Color fundus image; 45° FOV; 2212x1659:
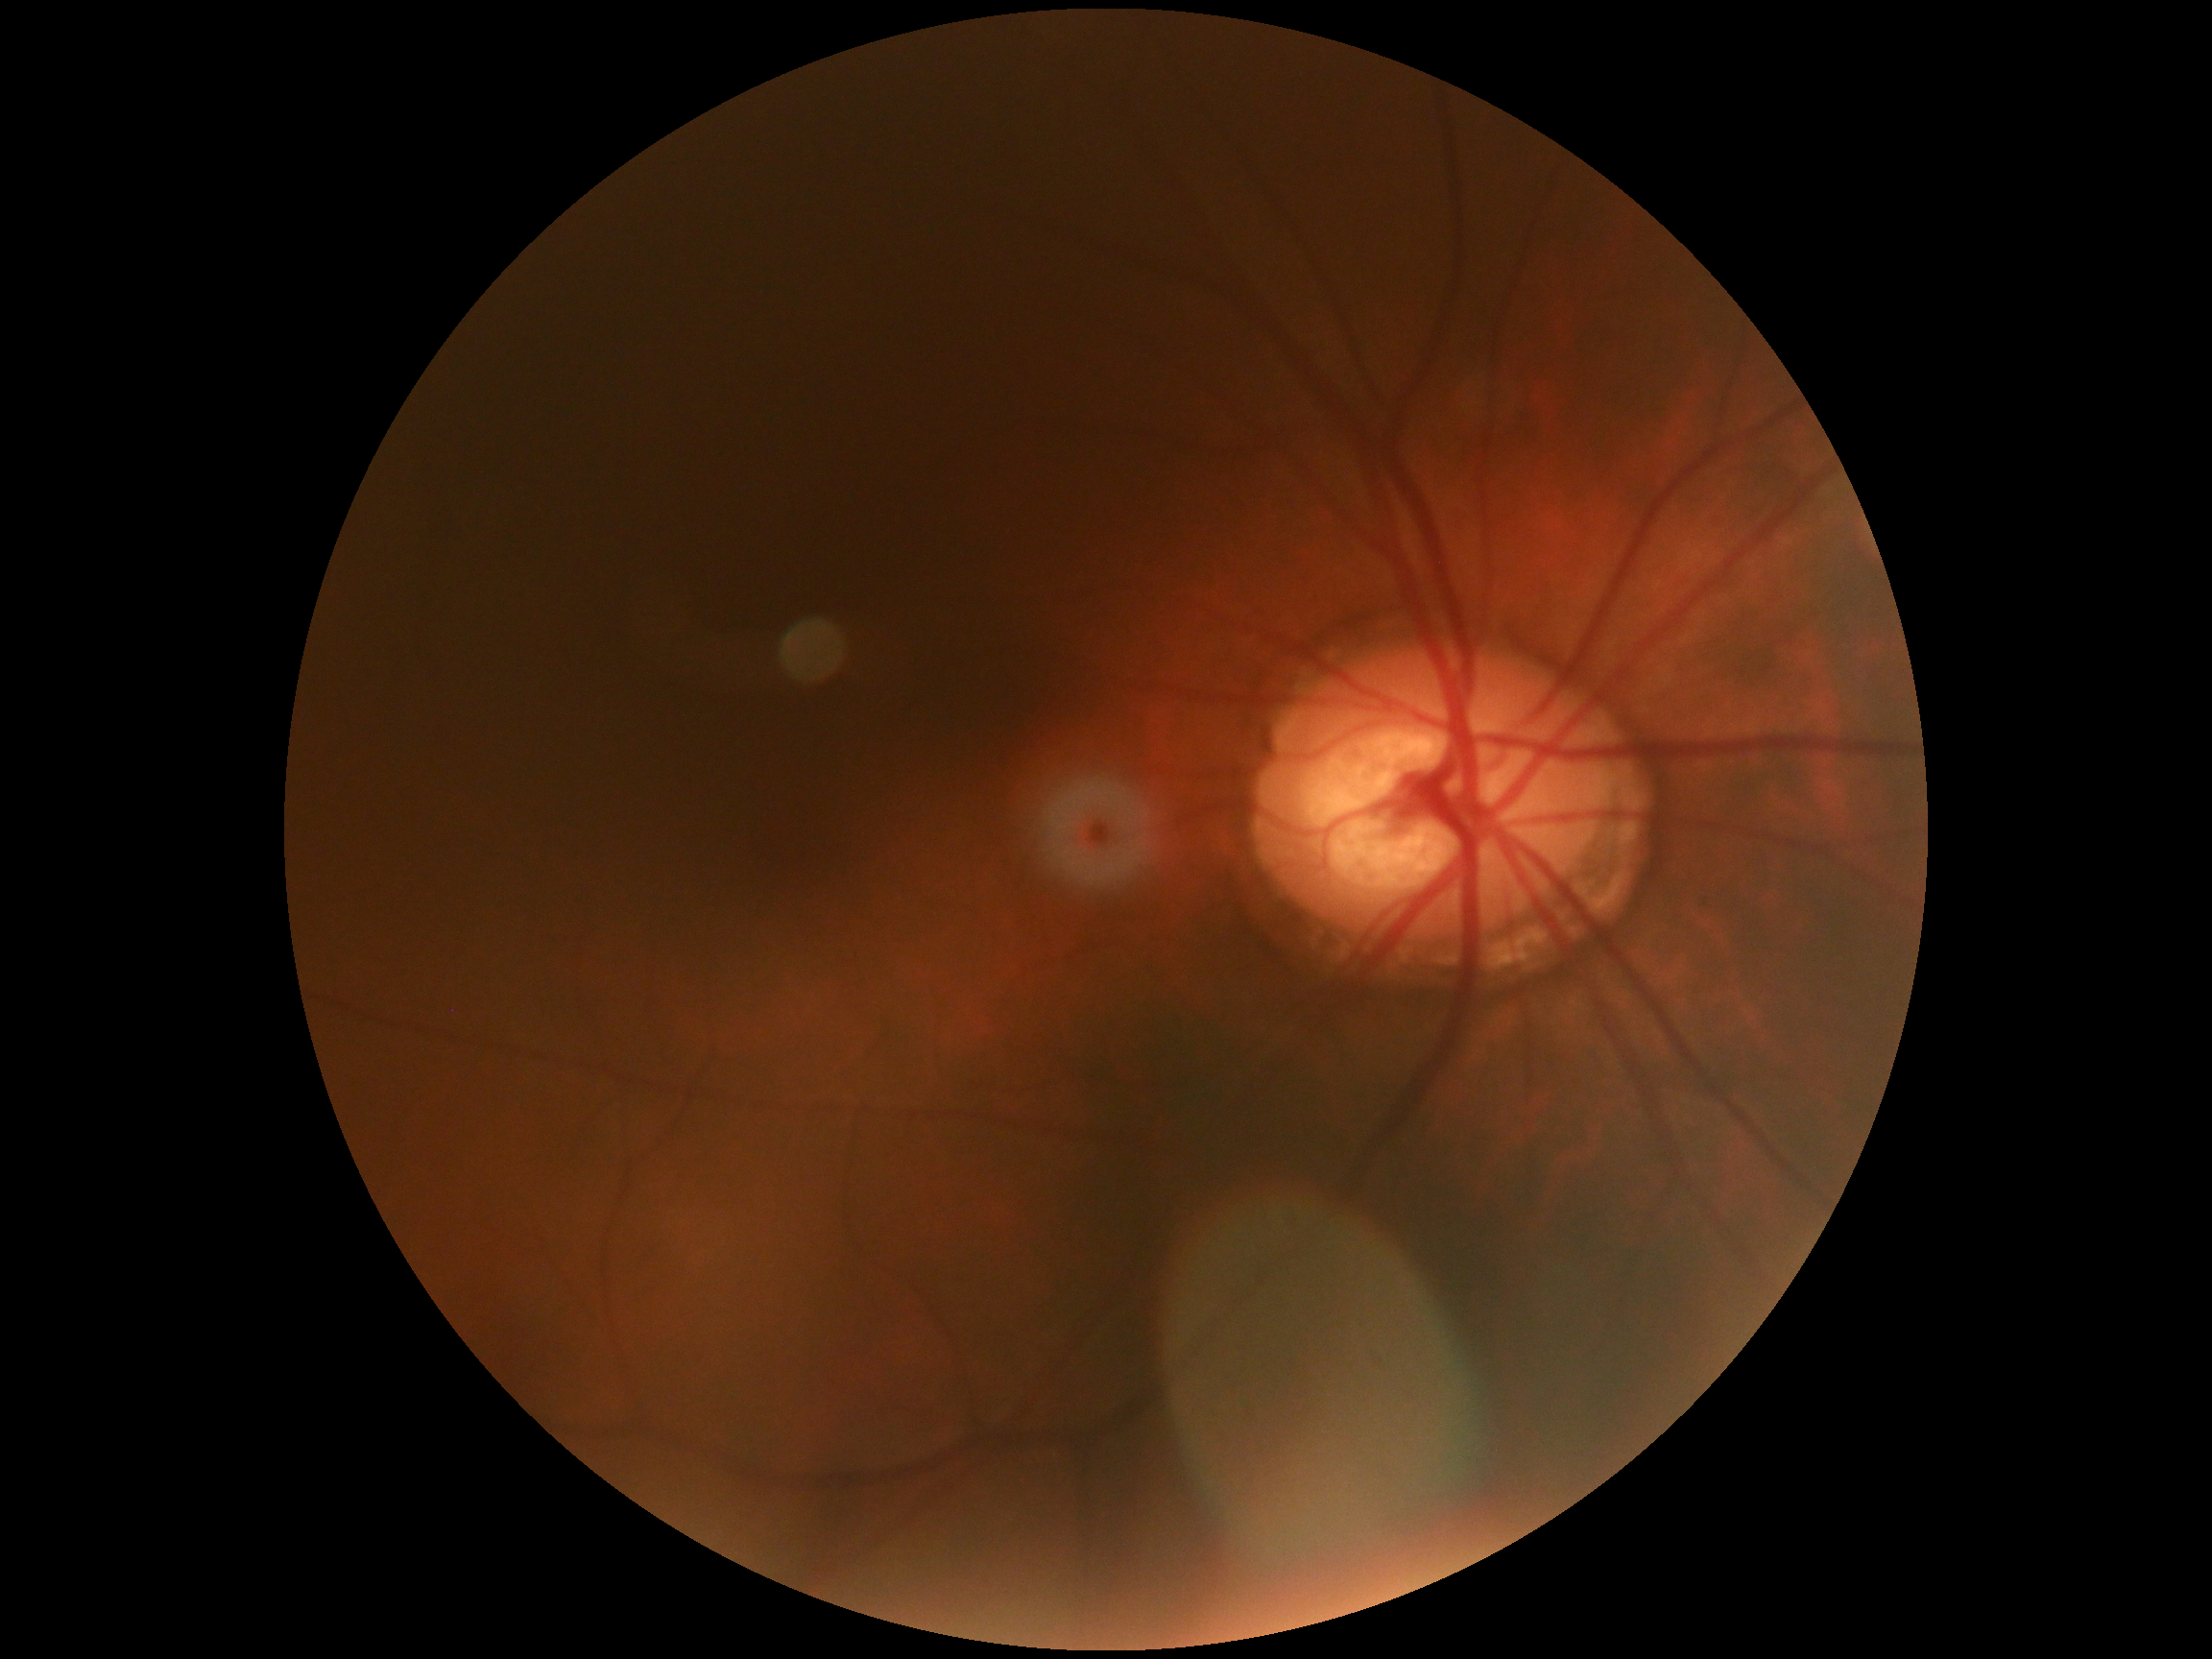 diabetic retinopathy (DR) = grade 0 (no apparent retinopathy) — no visible signs of diabetic retinopathy.